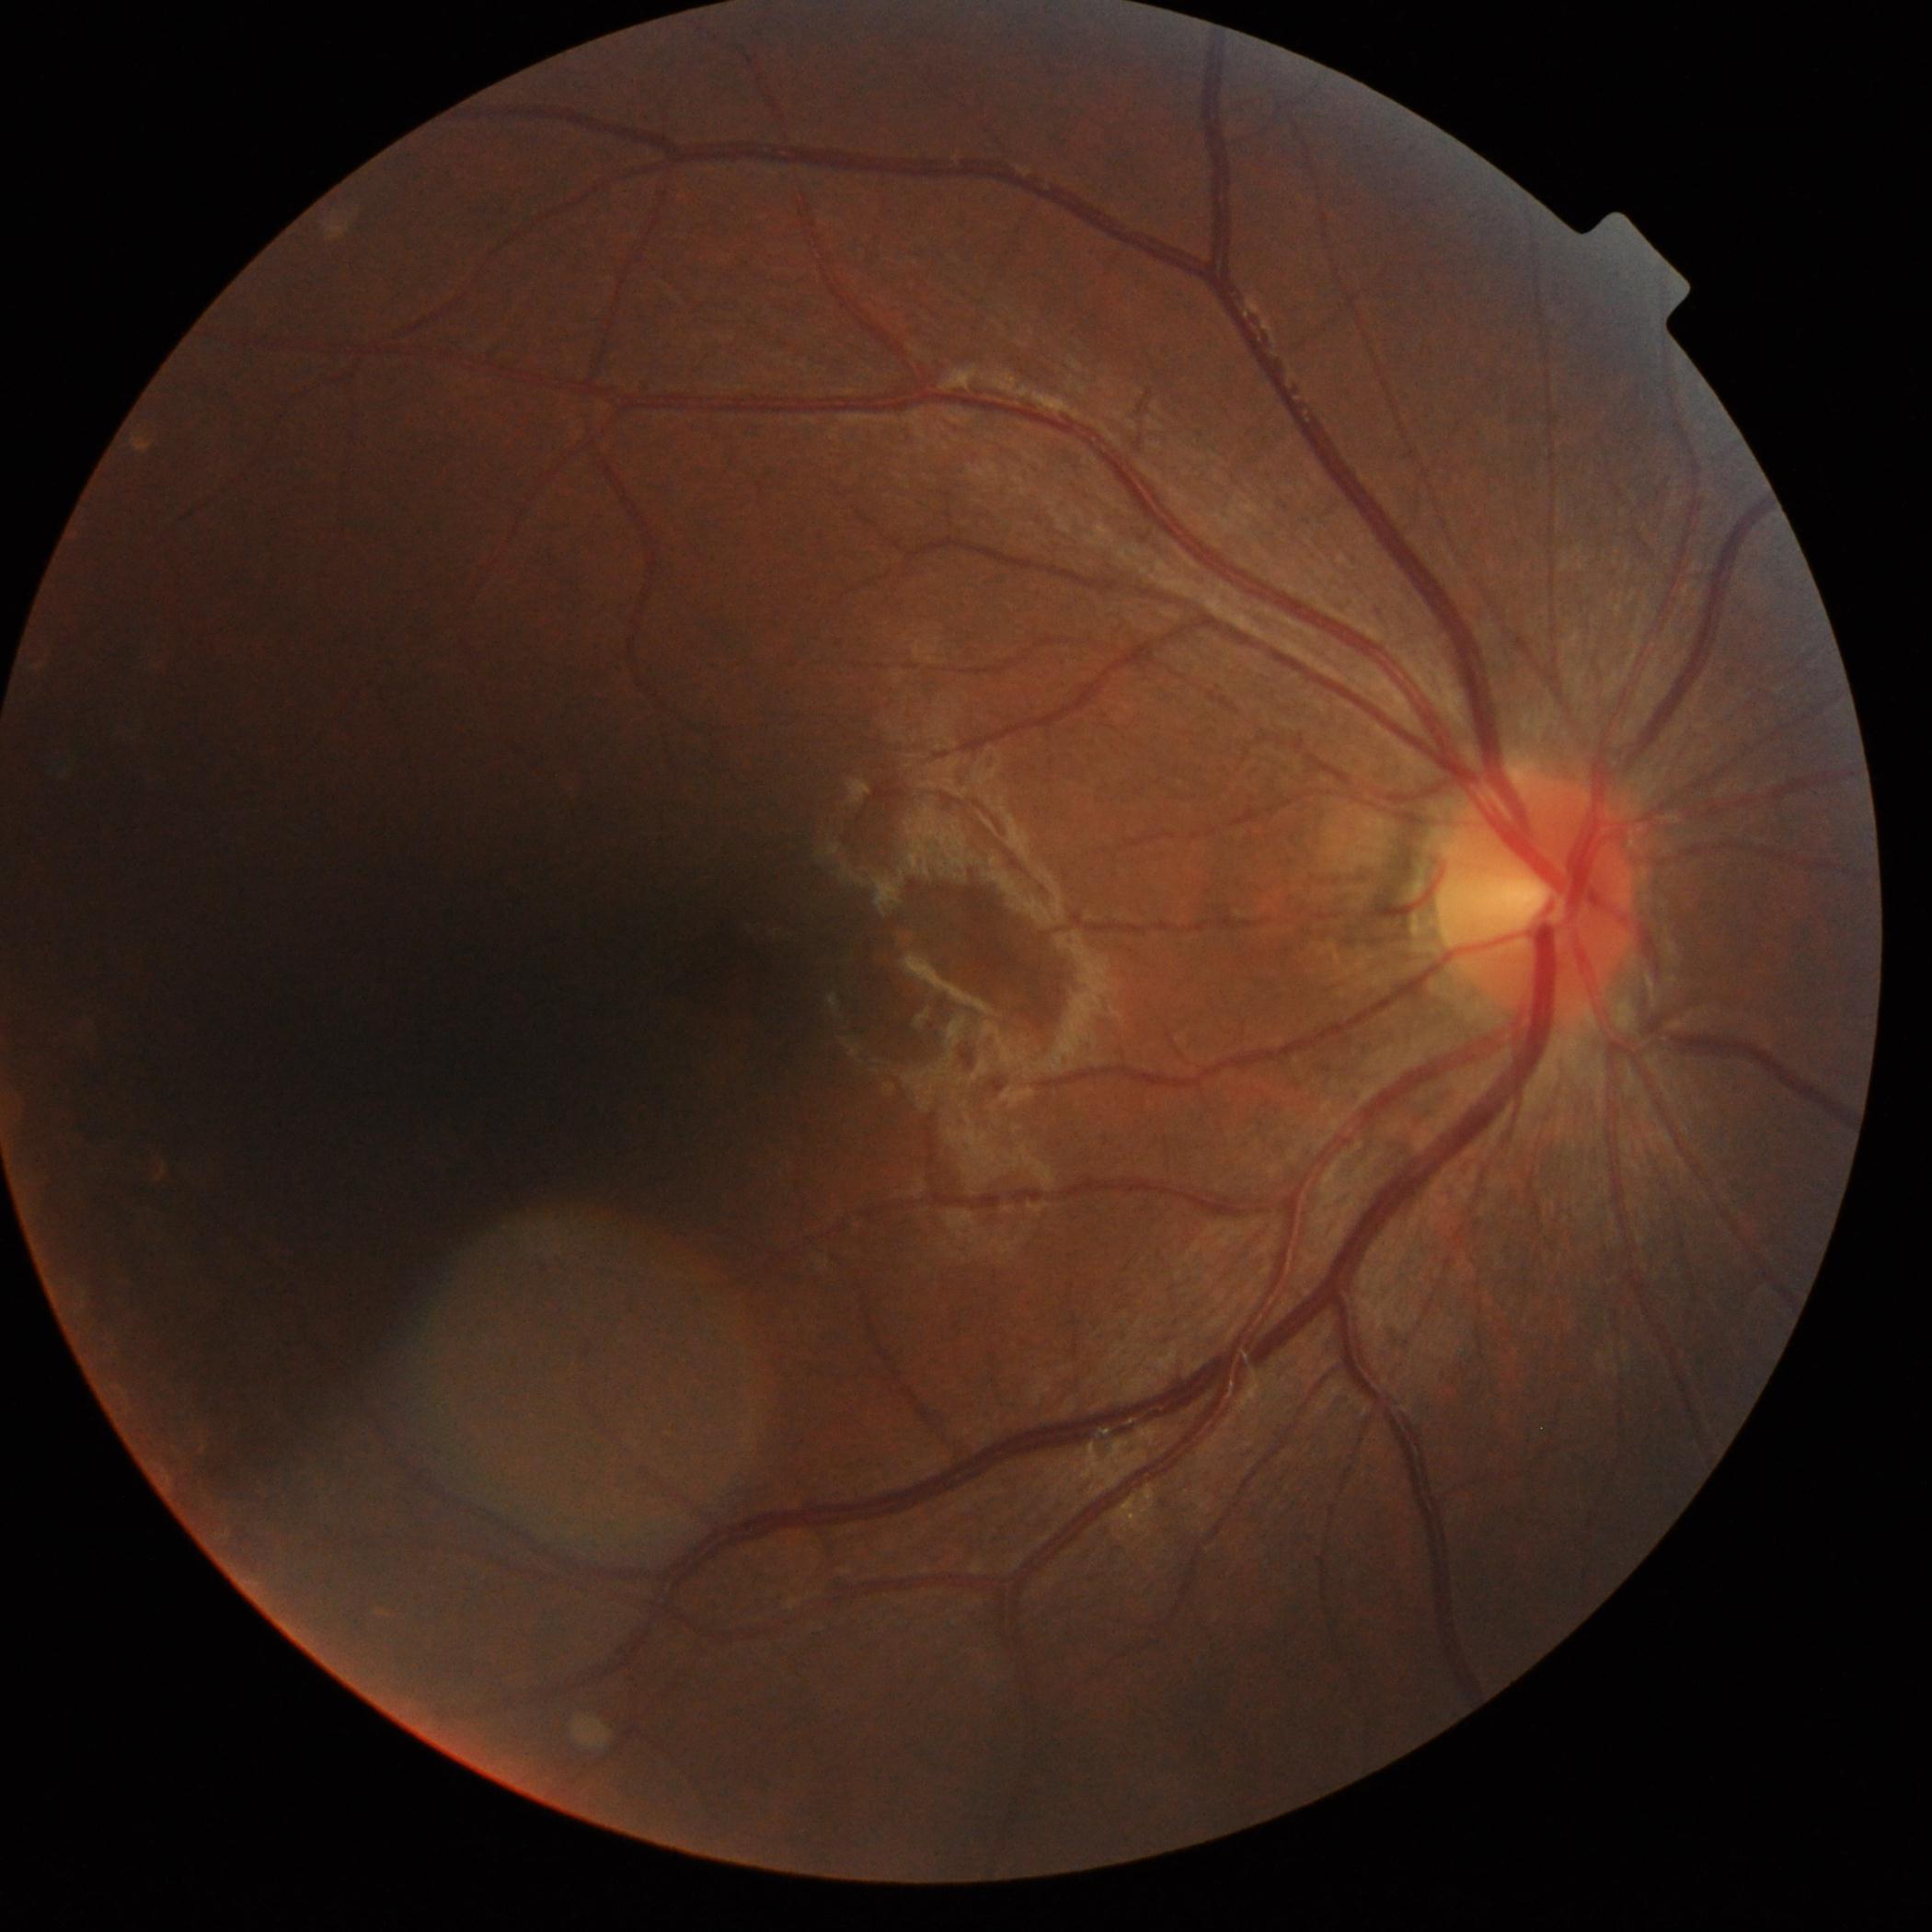
DR impression = no DR findings, retinopathy = grade 0 (no apparent retinopathy).